Wide-field fundus image from infant ROP screening · 640 x 480 pixels
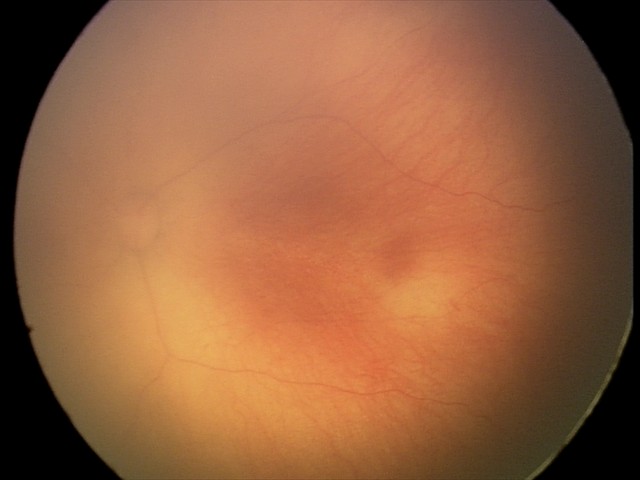

No plus disease. Series diagnosed as retinopathy of prematurity (ROP) stage 0.